Pediatric wide-field fundus photograph:
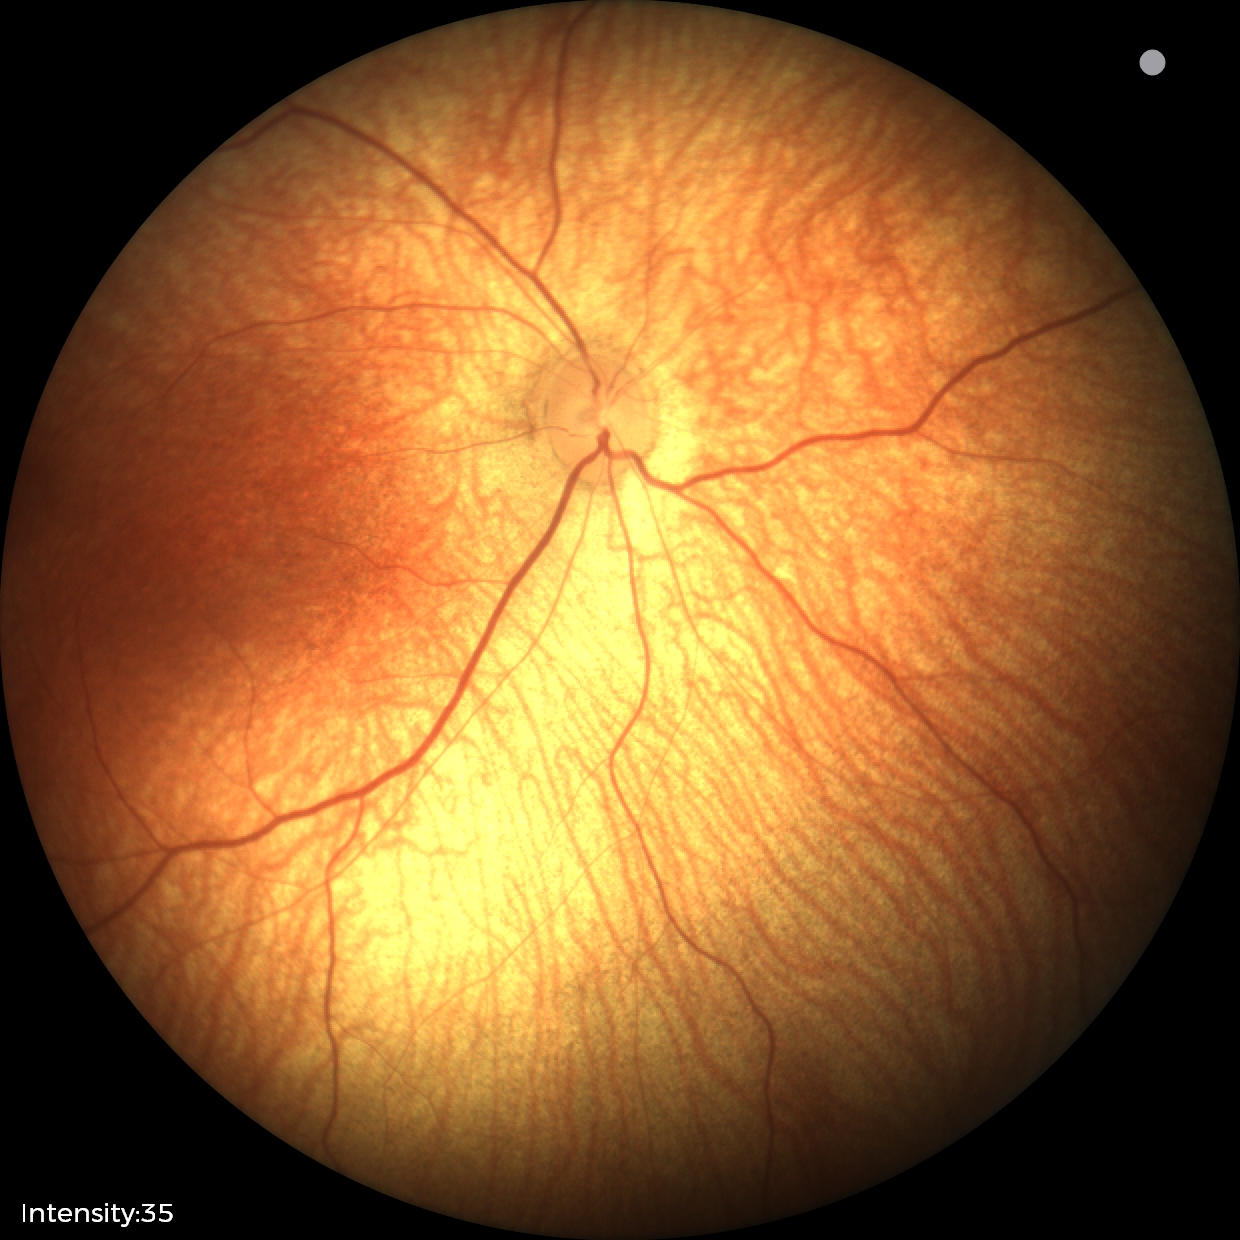

Impression: physiological appearance with no retinal pathology.